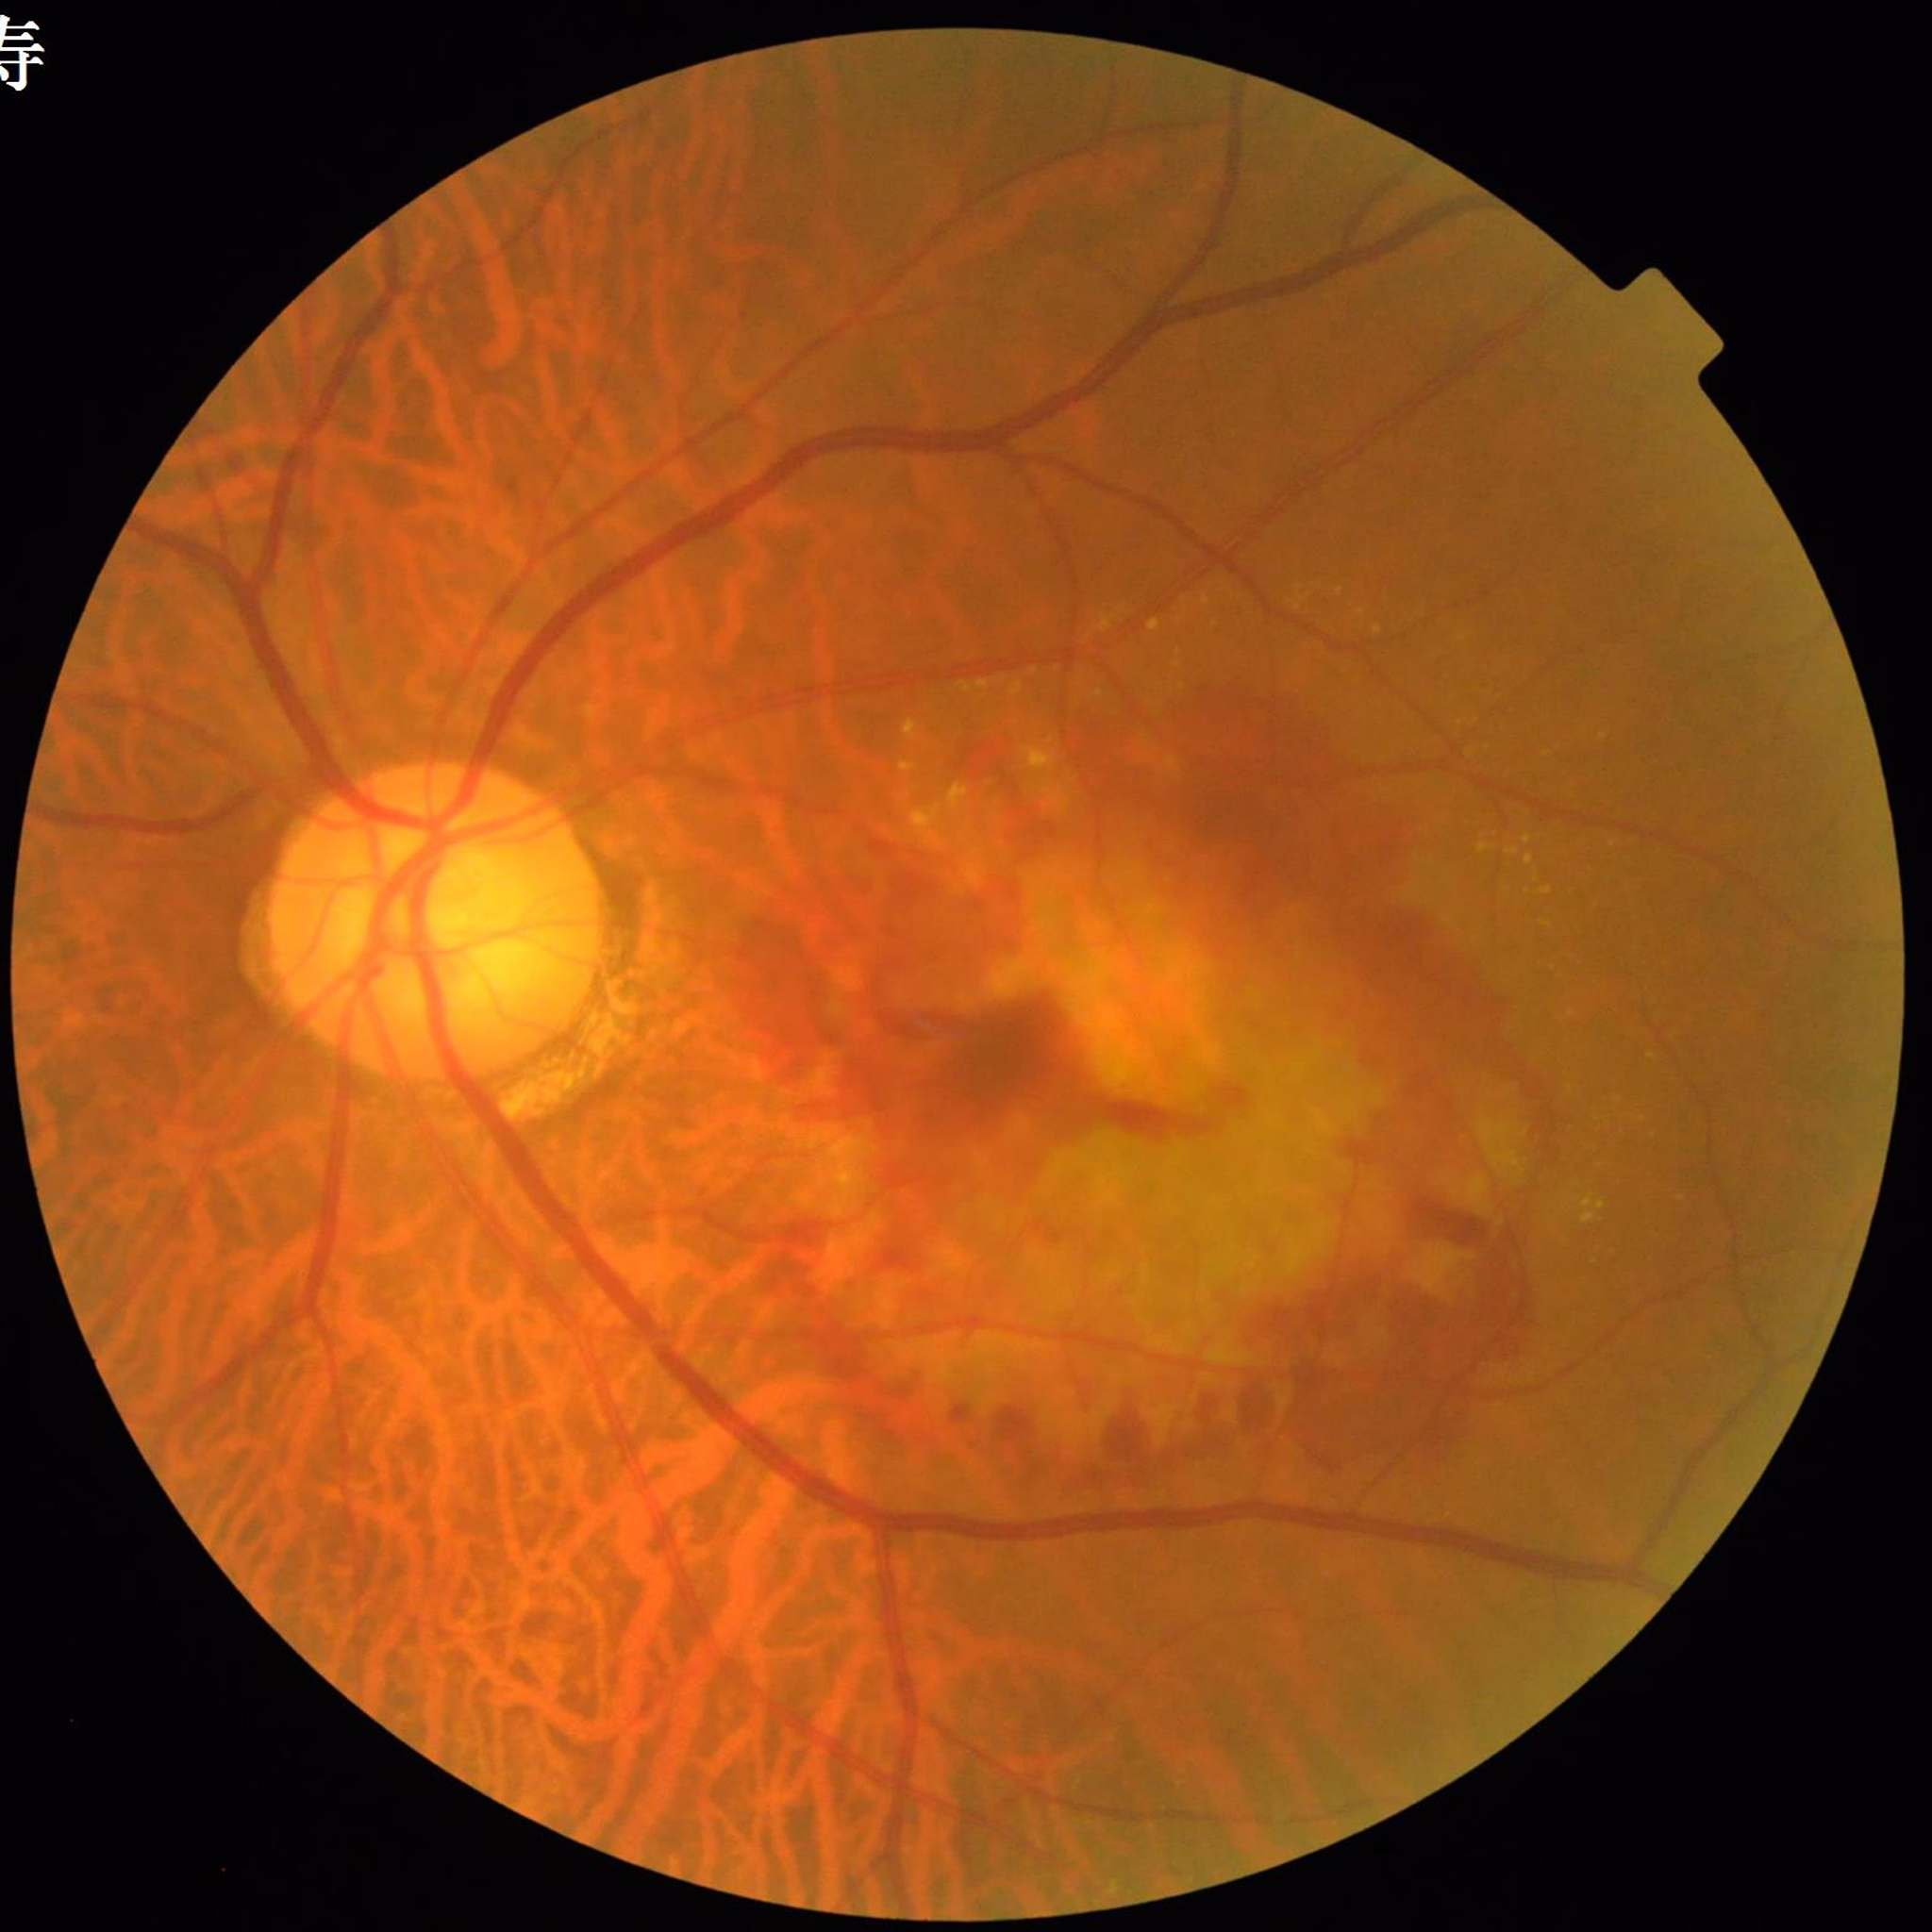 {"image_quality": "no concerns identified", "diagnosis": "age-related macular degeneration"}